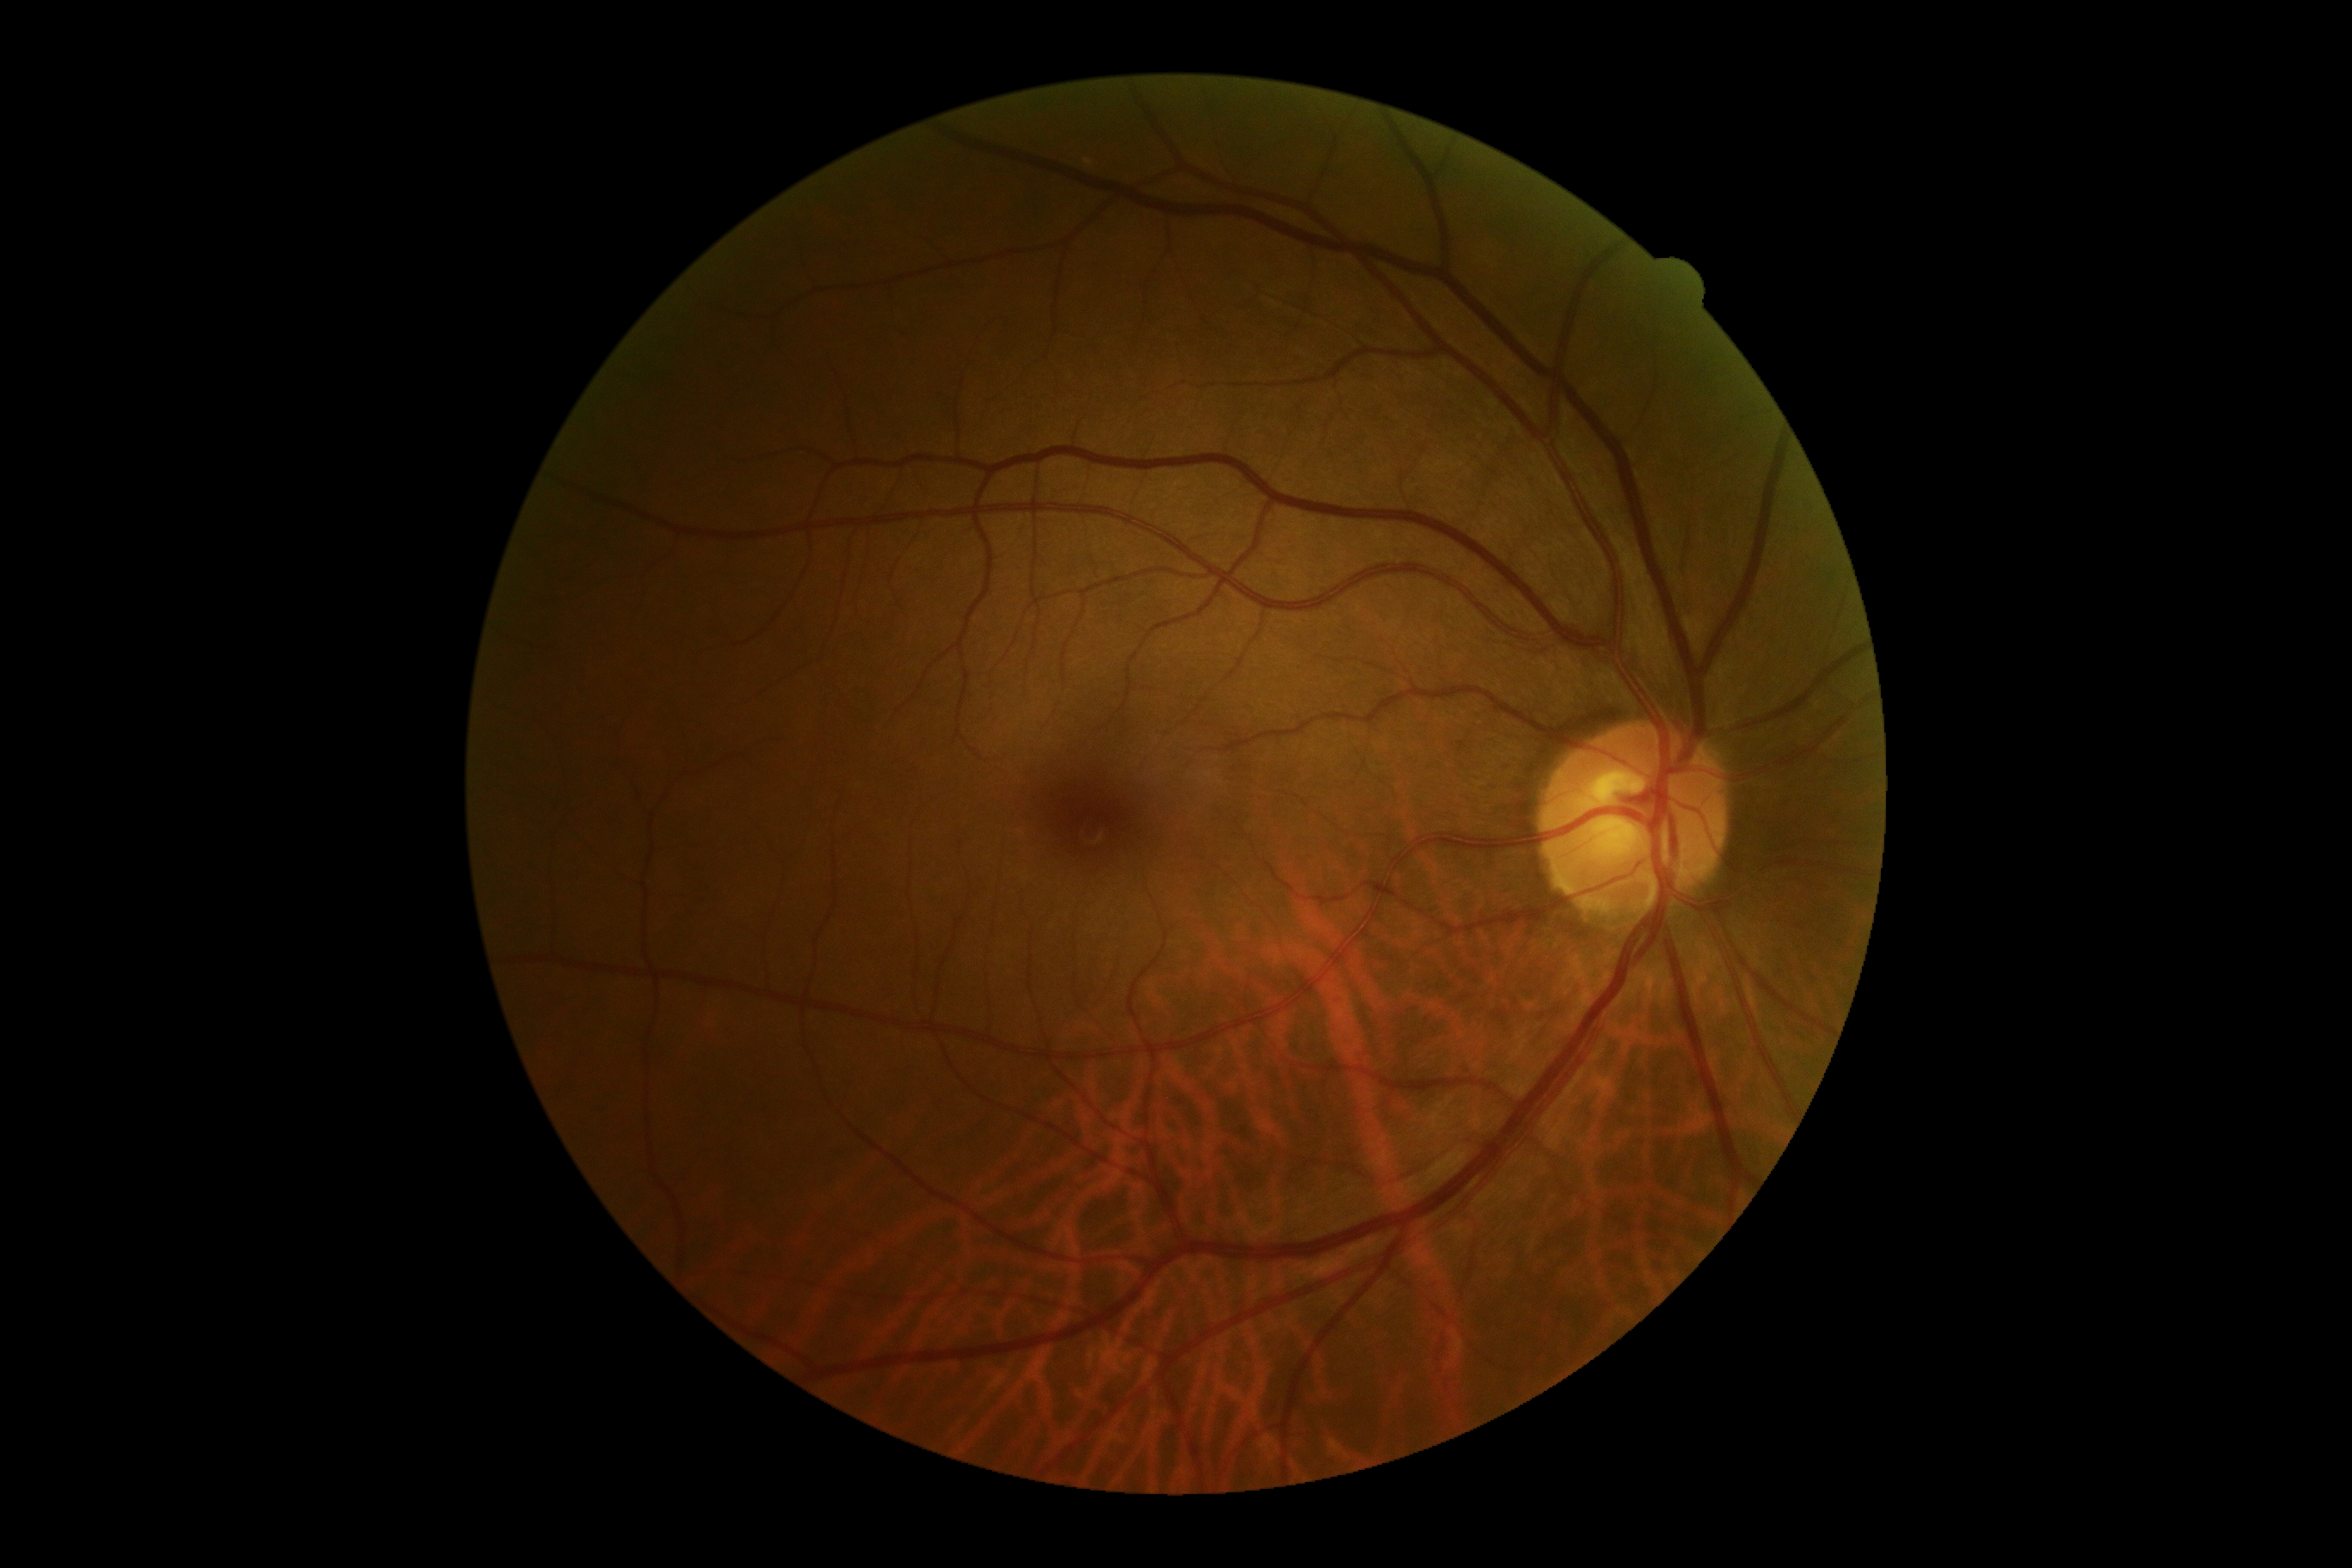
DR severity: grade 0 (no apparent retinopathy).